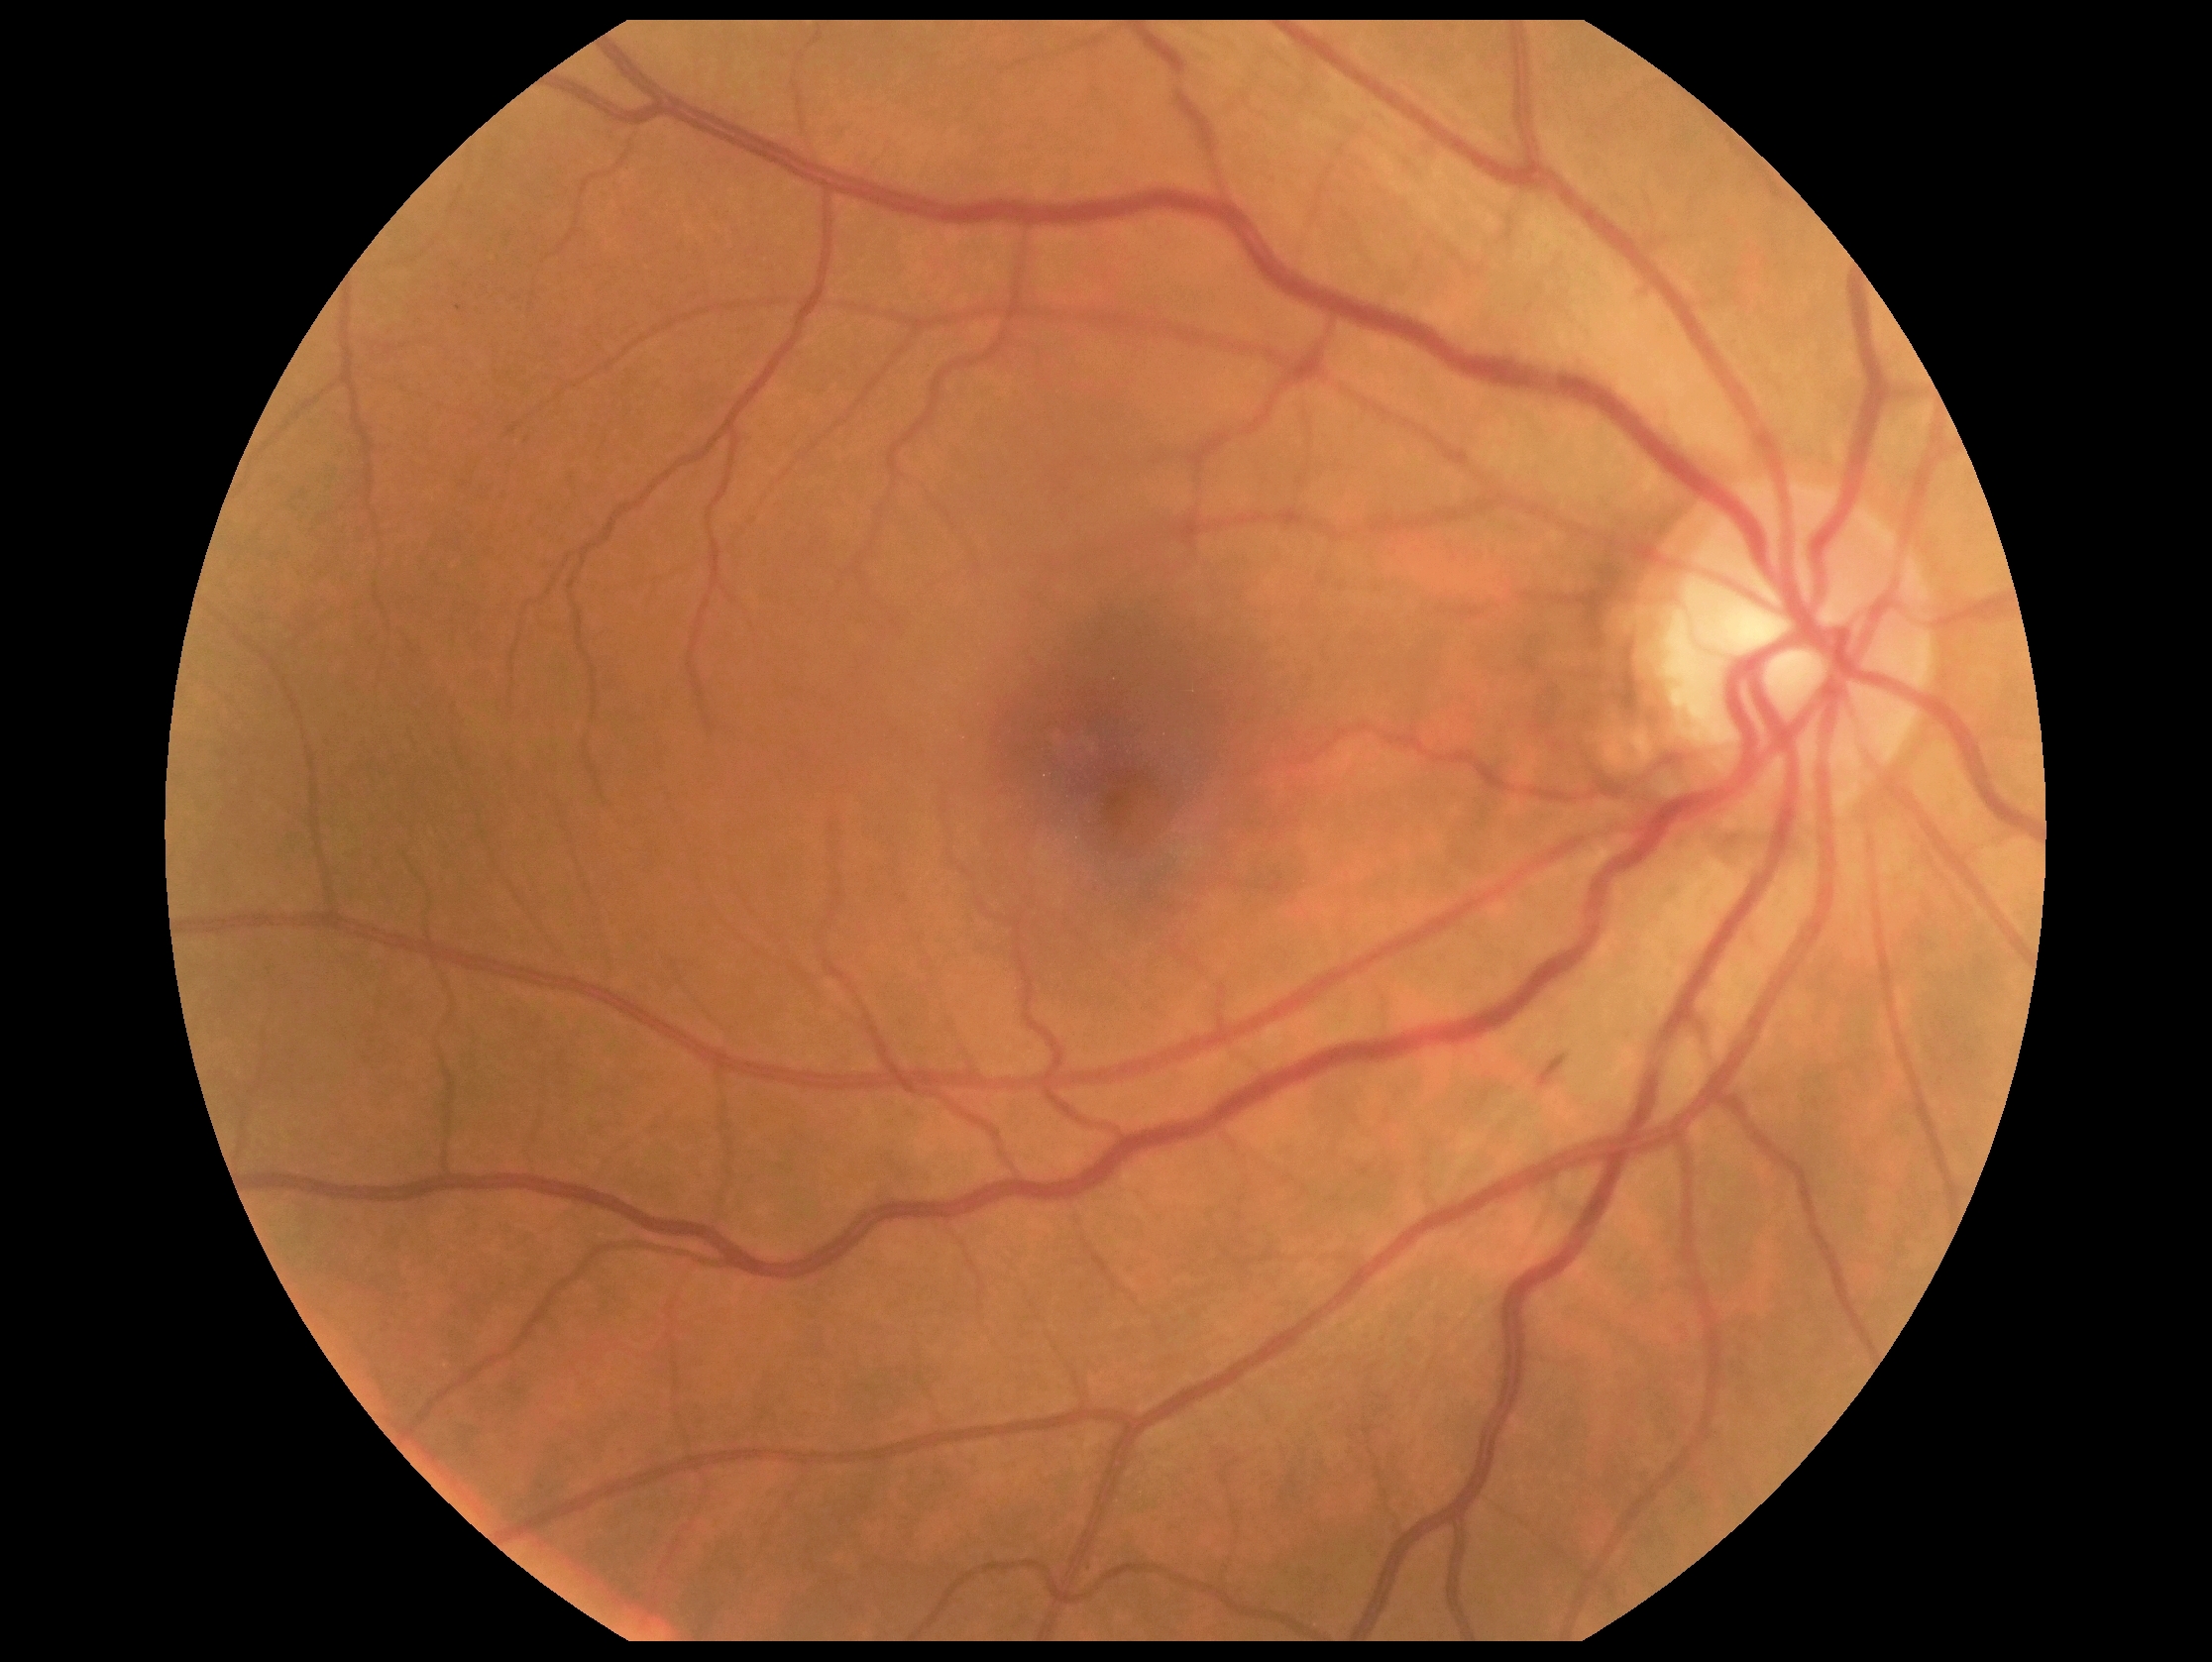

Diabetic retinopathy is moderate non-proliferative diabetic retinopathy (grade 2).